Fundus photo; image size 2102x1736: 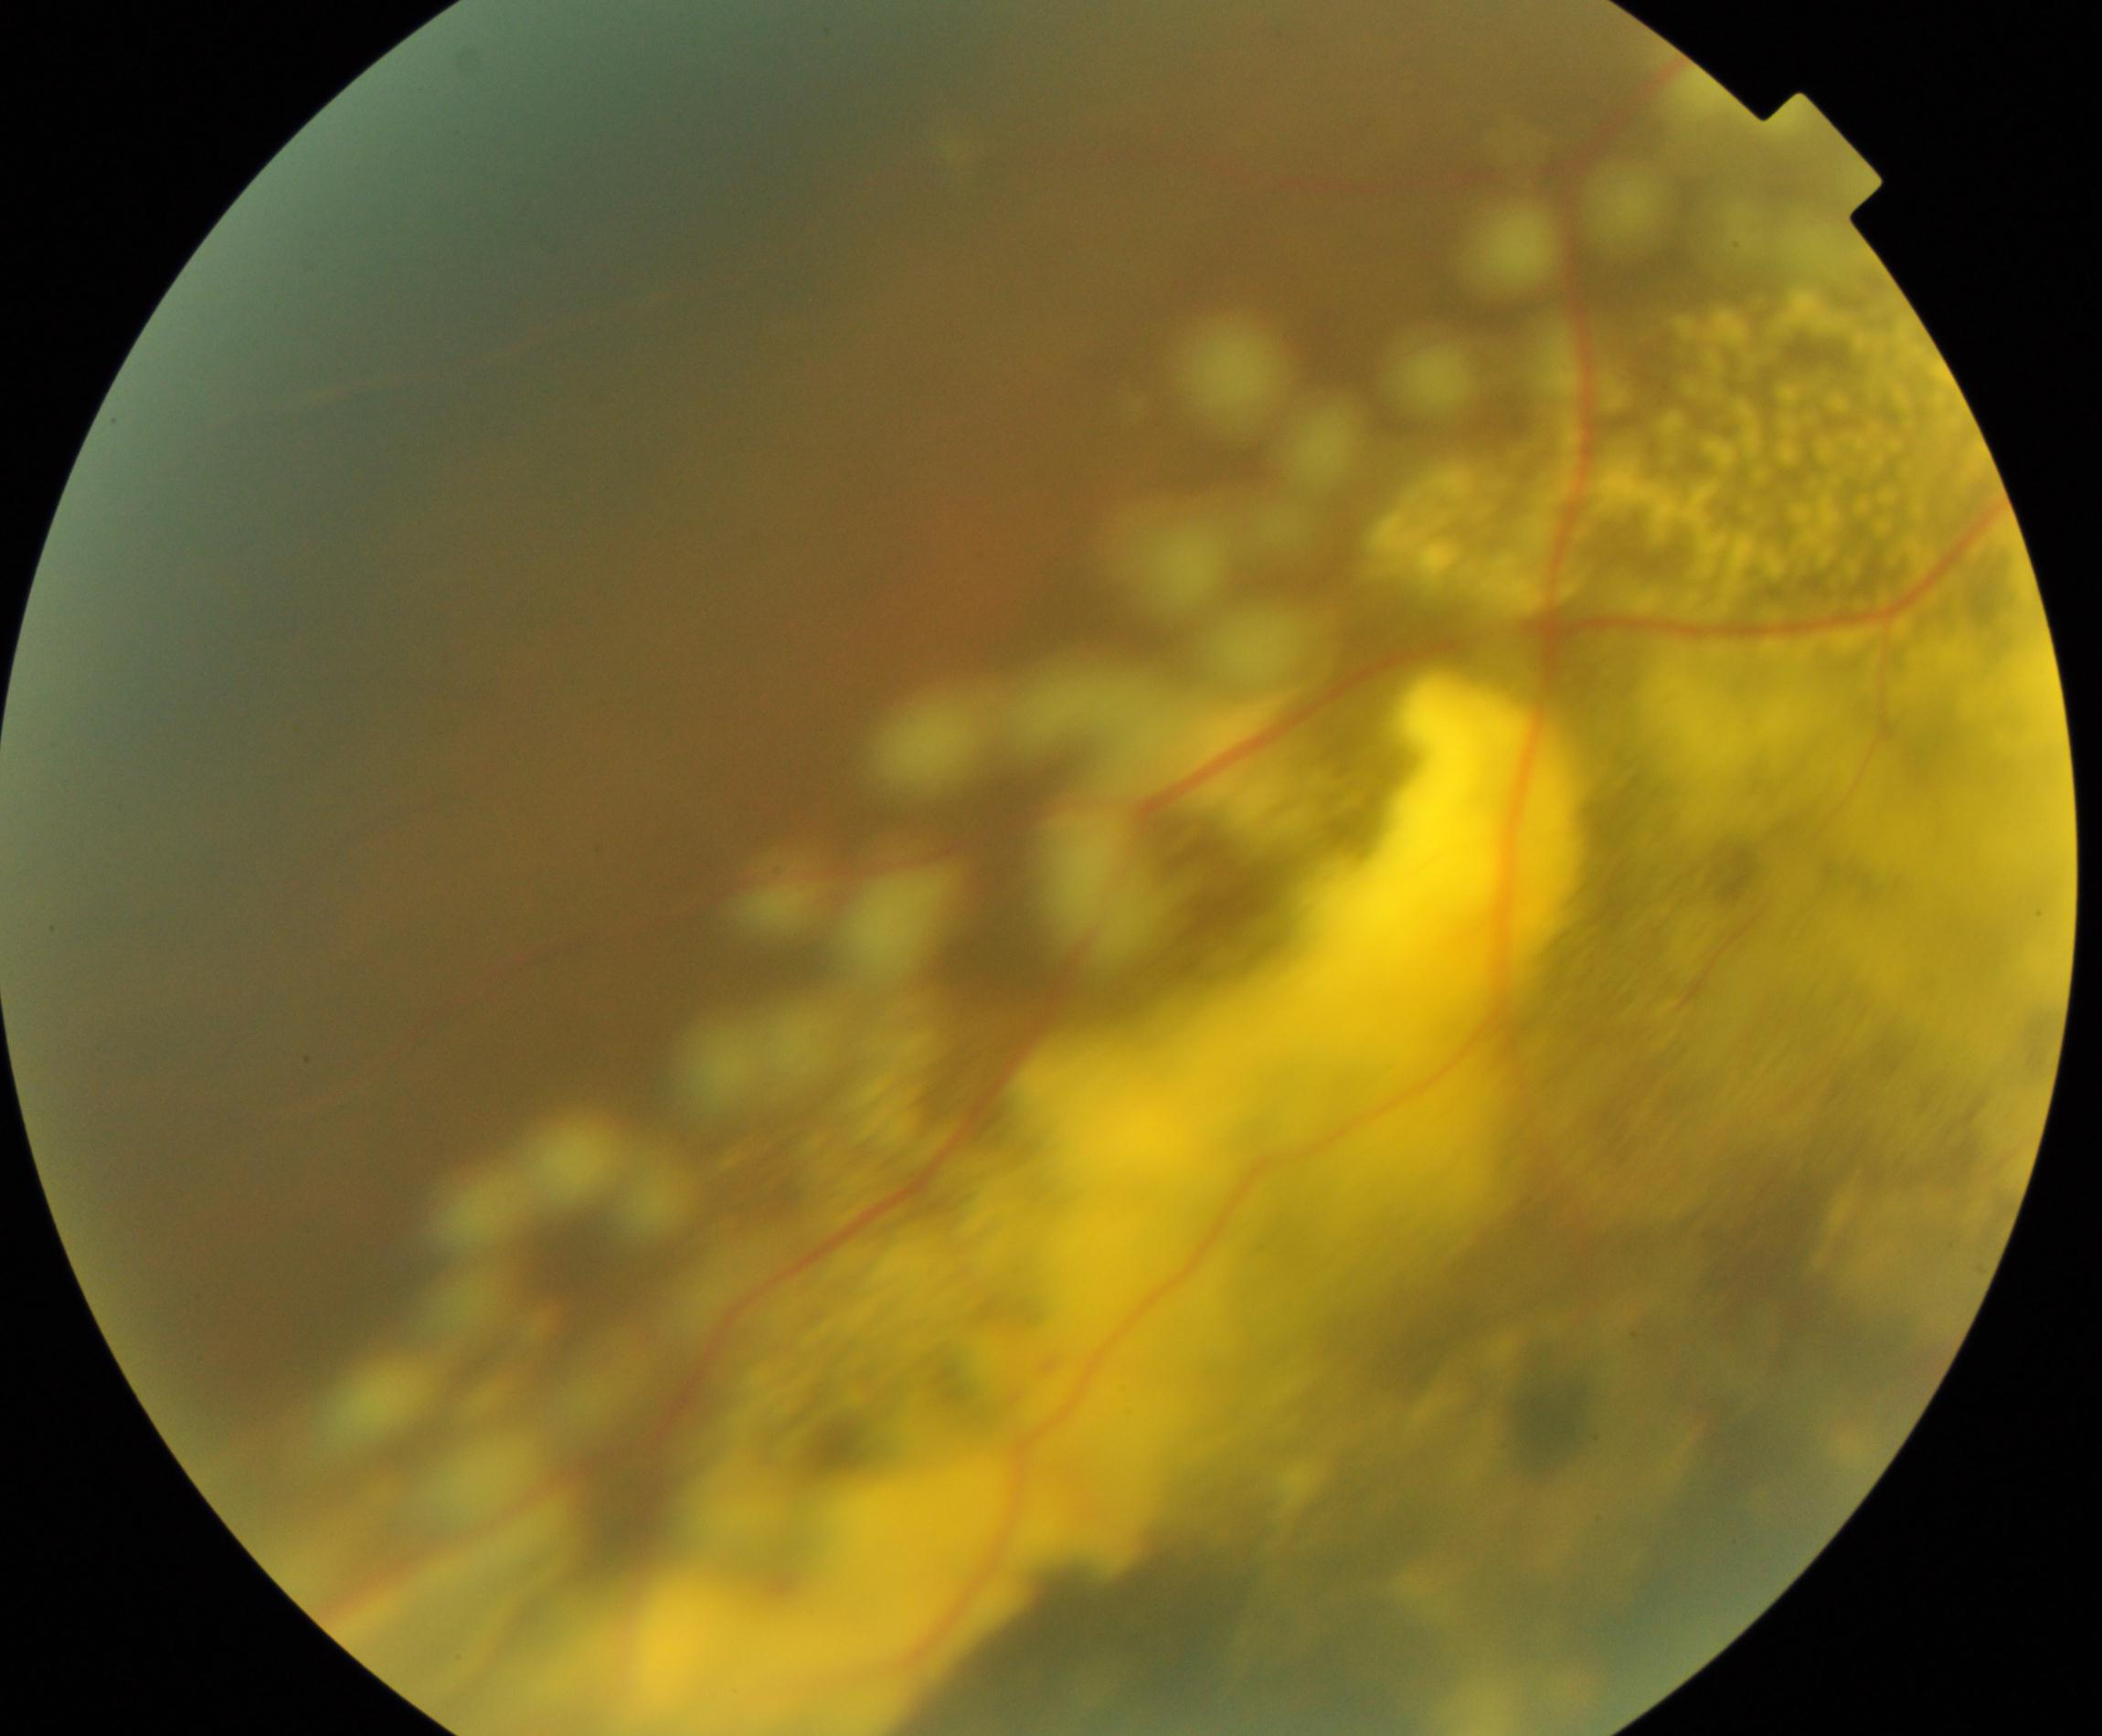
The image shows massive hard exudates.